Wide-field fundus photograph from neonatal ROP screening — 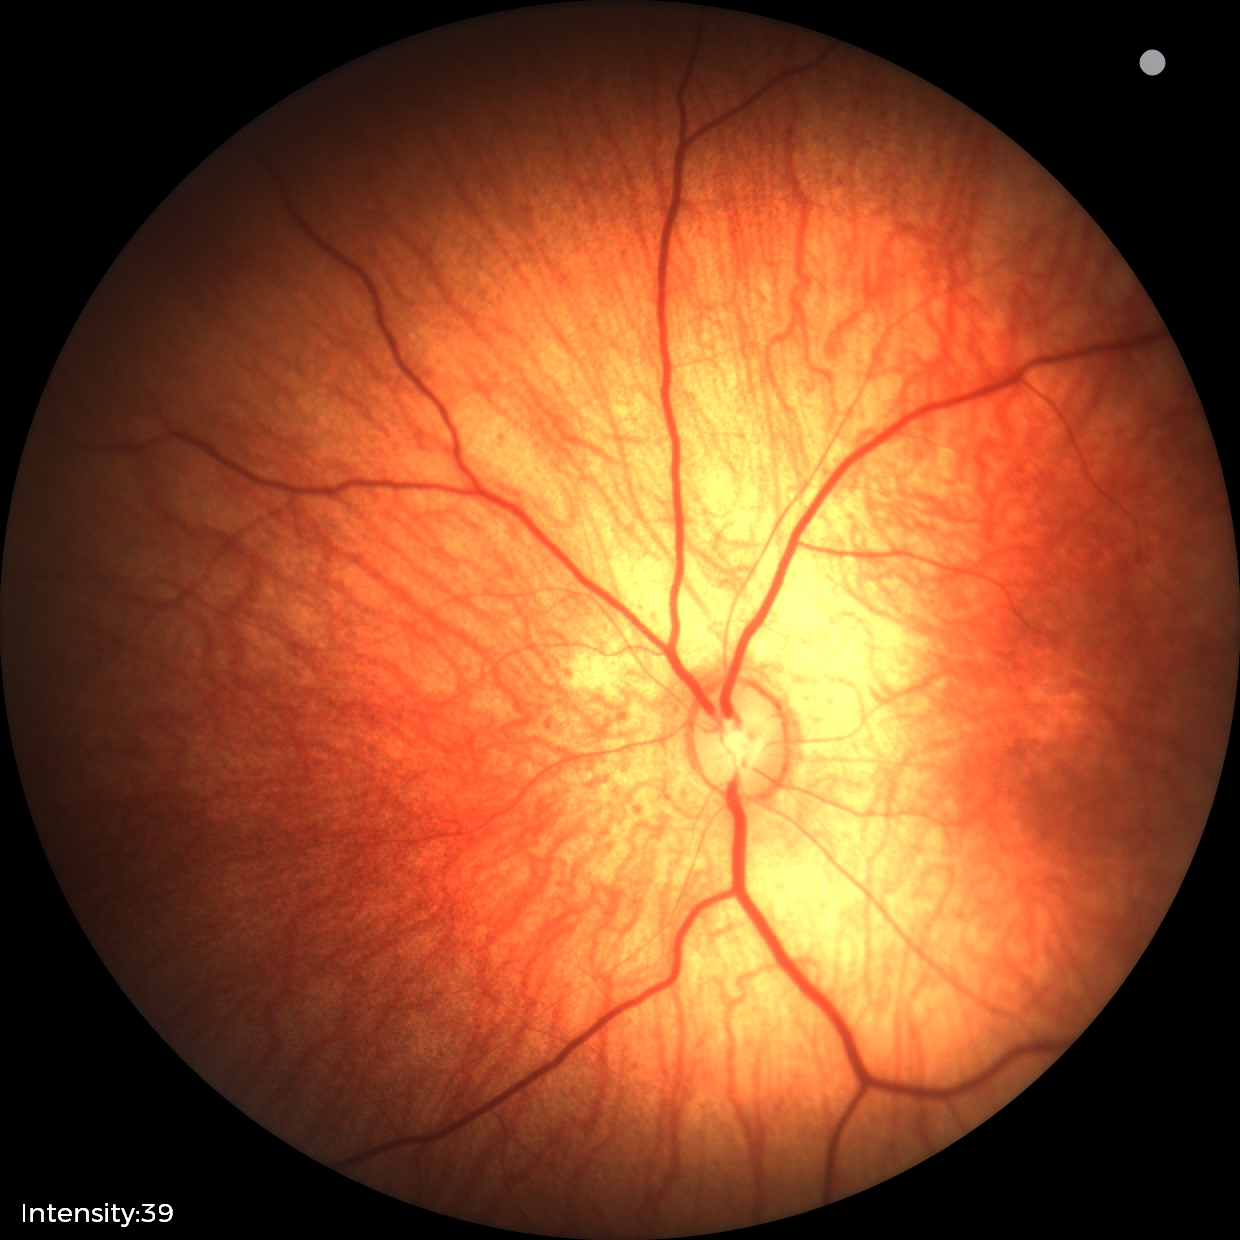 Assessment = physiological appearance